Modified Davis grading
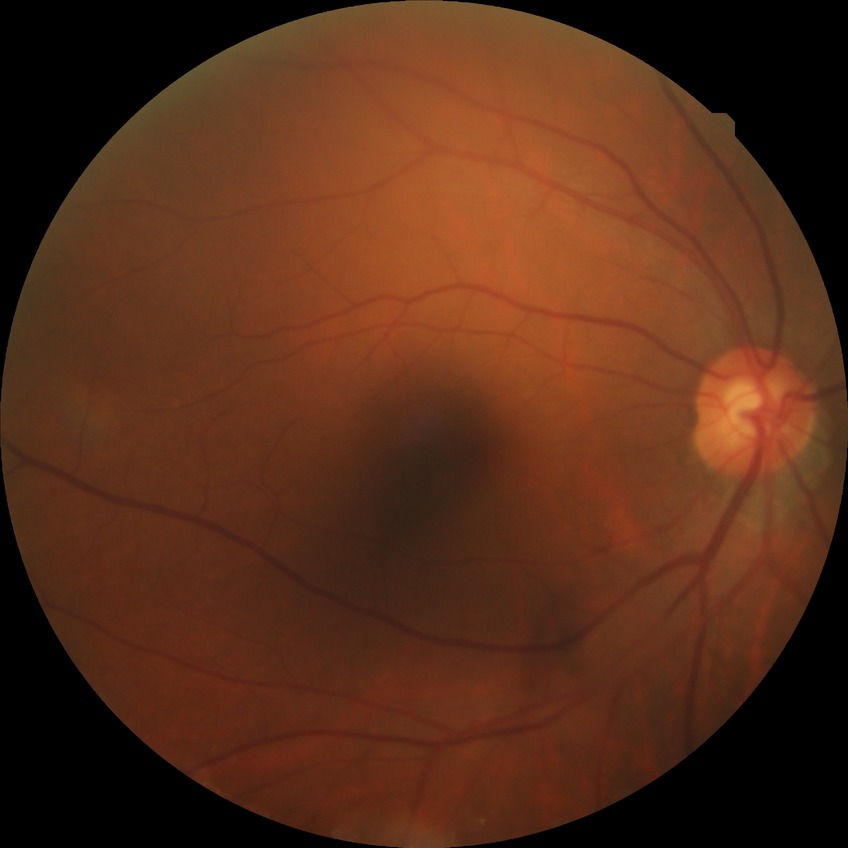 Diabetic retinopathy severity: no diabetic retinopathy.